Wide-field fundus image from infant ROP screening — 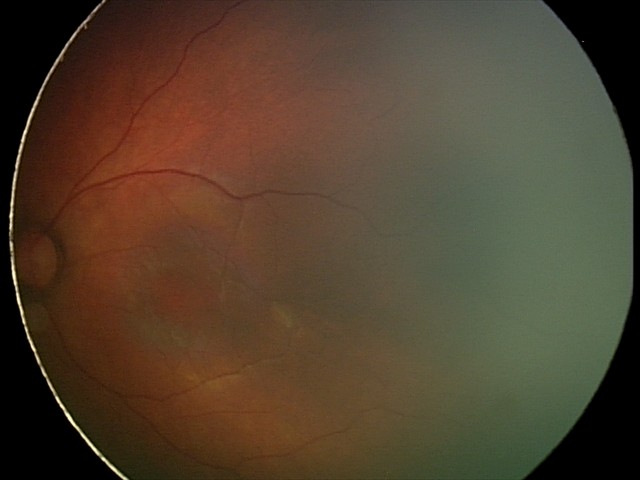
Diagnosis: physiological.